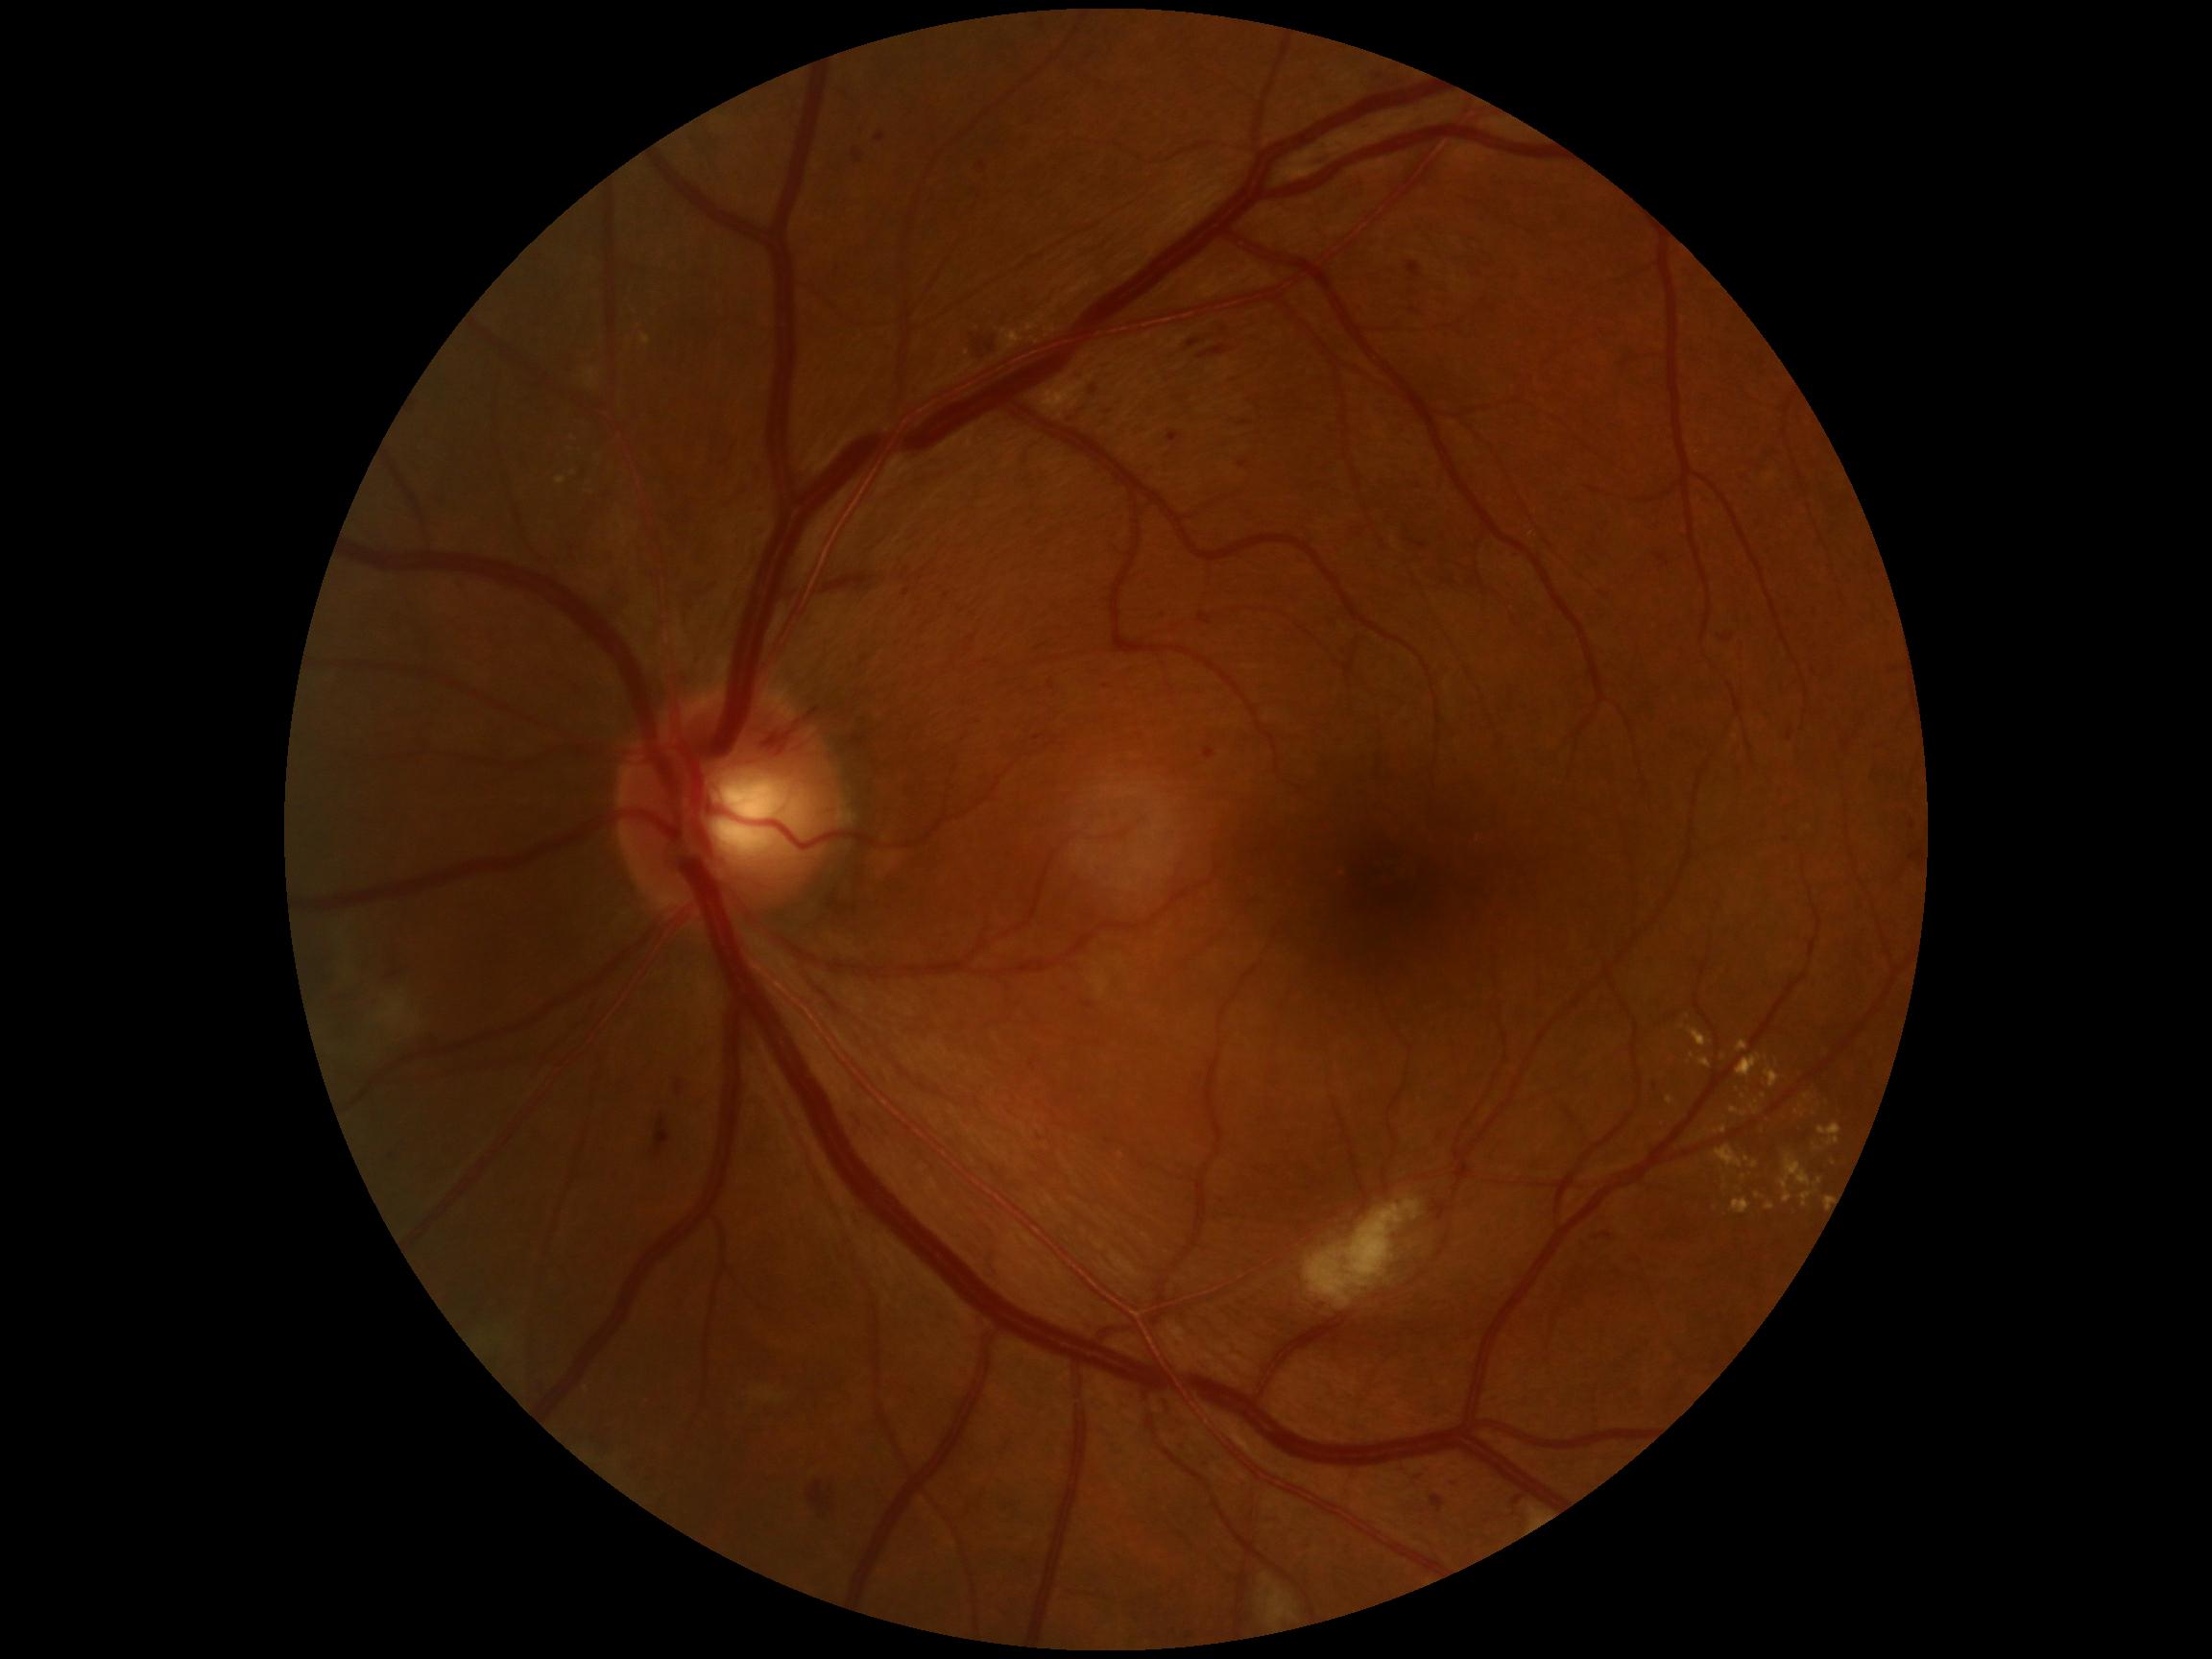   dr_grade: 2 (moderate NPDR)
  dr_category: non-proliferative diabetic retinopathy